Posterior pole field covering the optic disc and macula — 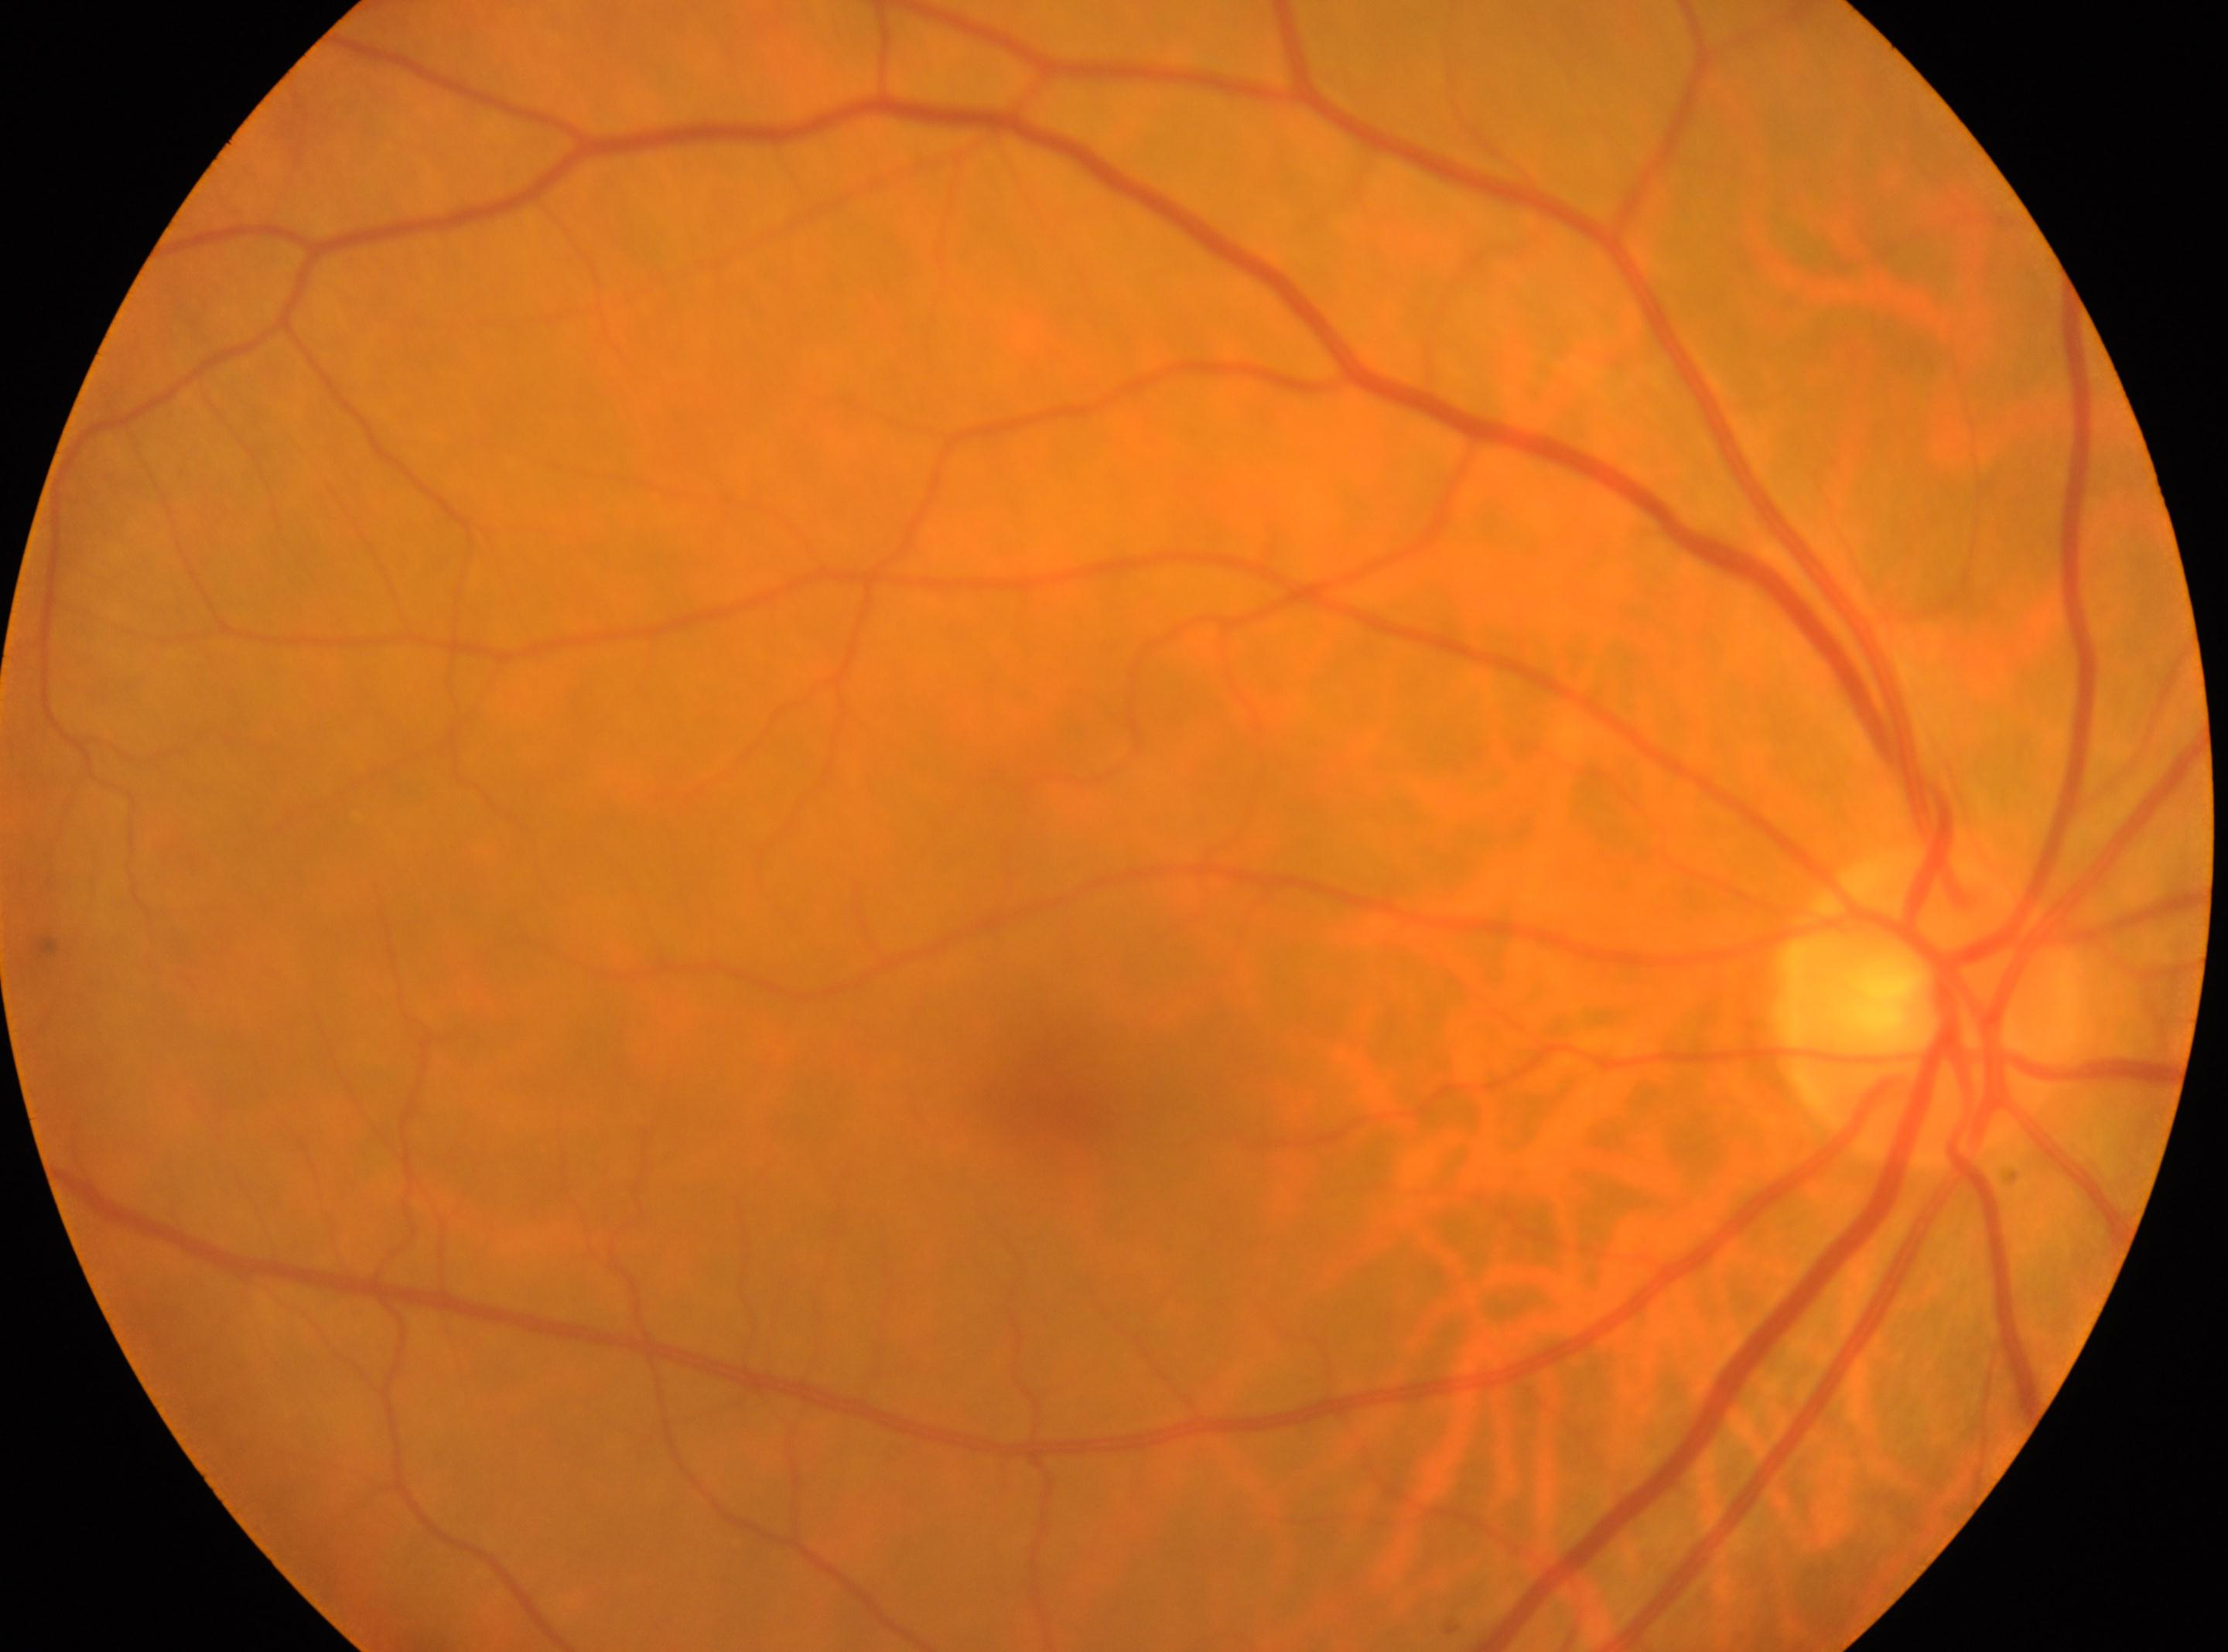 DR: grade 0 (no apparent retinopathy).
Imaged eye: the right eye.
Foveal center: 1047px, 1097px.
Optic disc located at 1926px, 1005px.